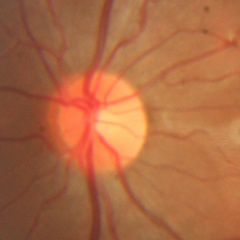
This fundus photograph shows no glaucomatous optic neuropathy.